Fundus photo taken with a portable handheld camera:
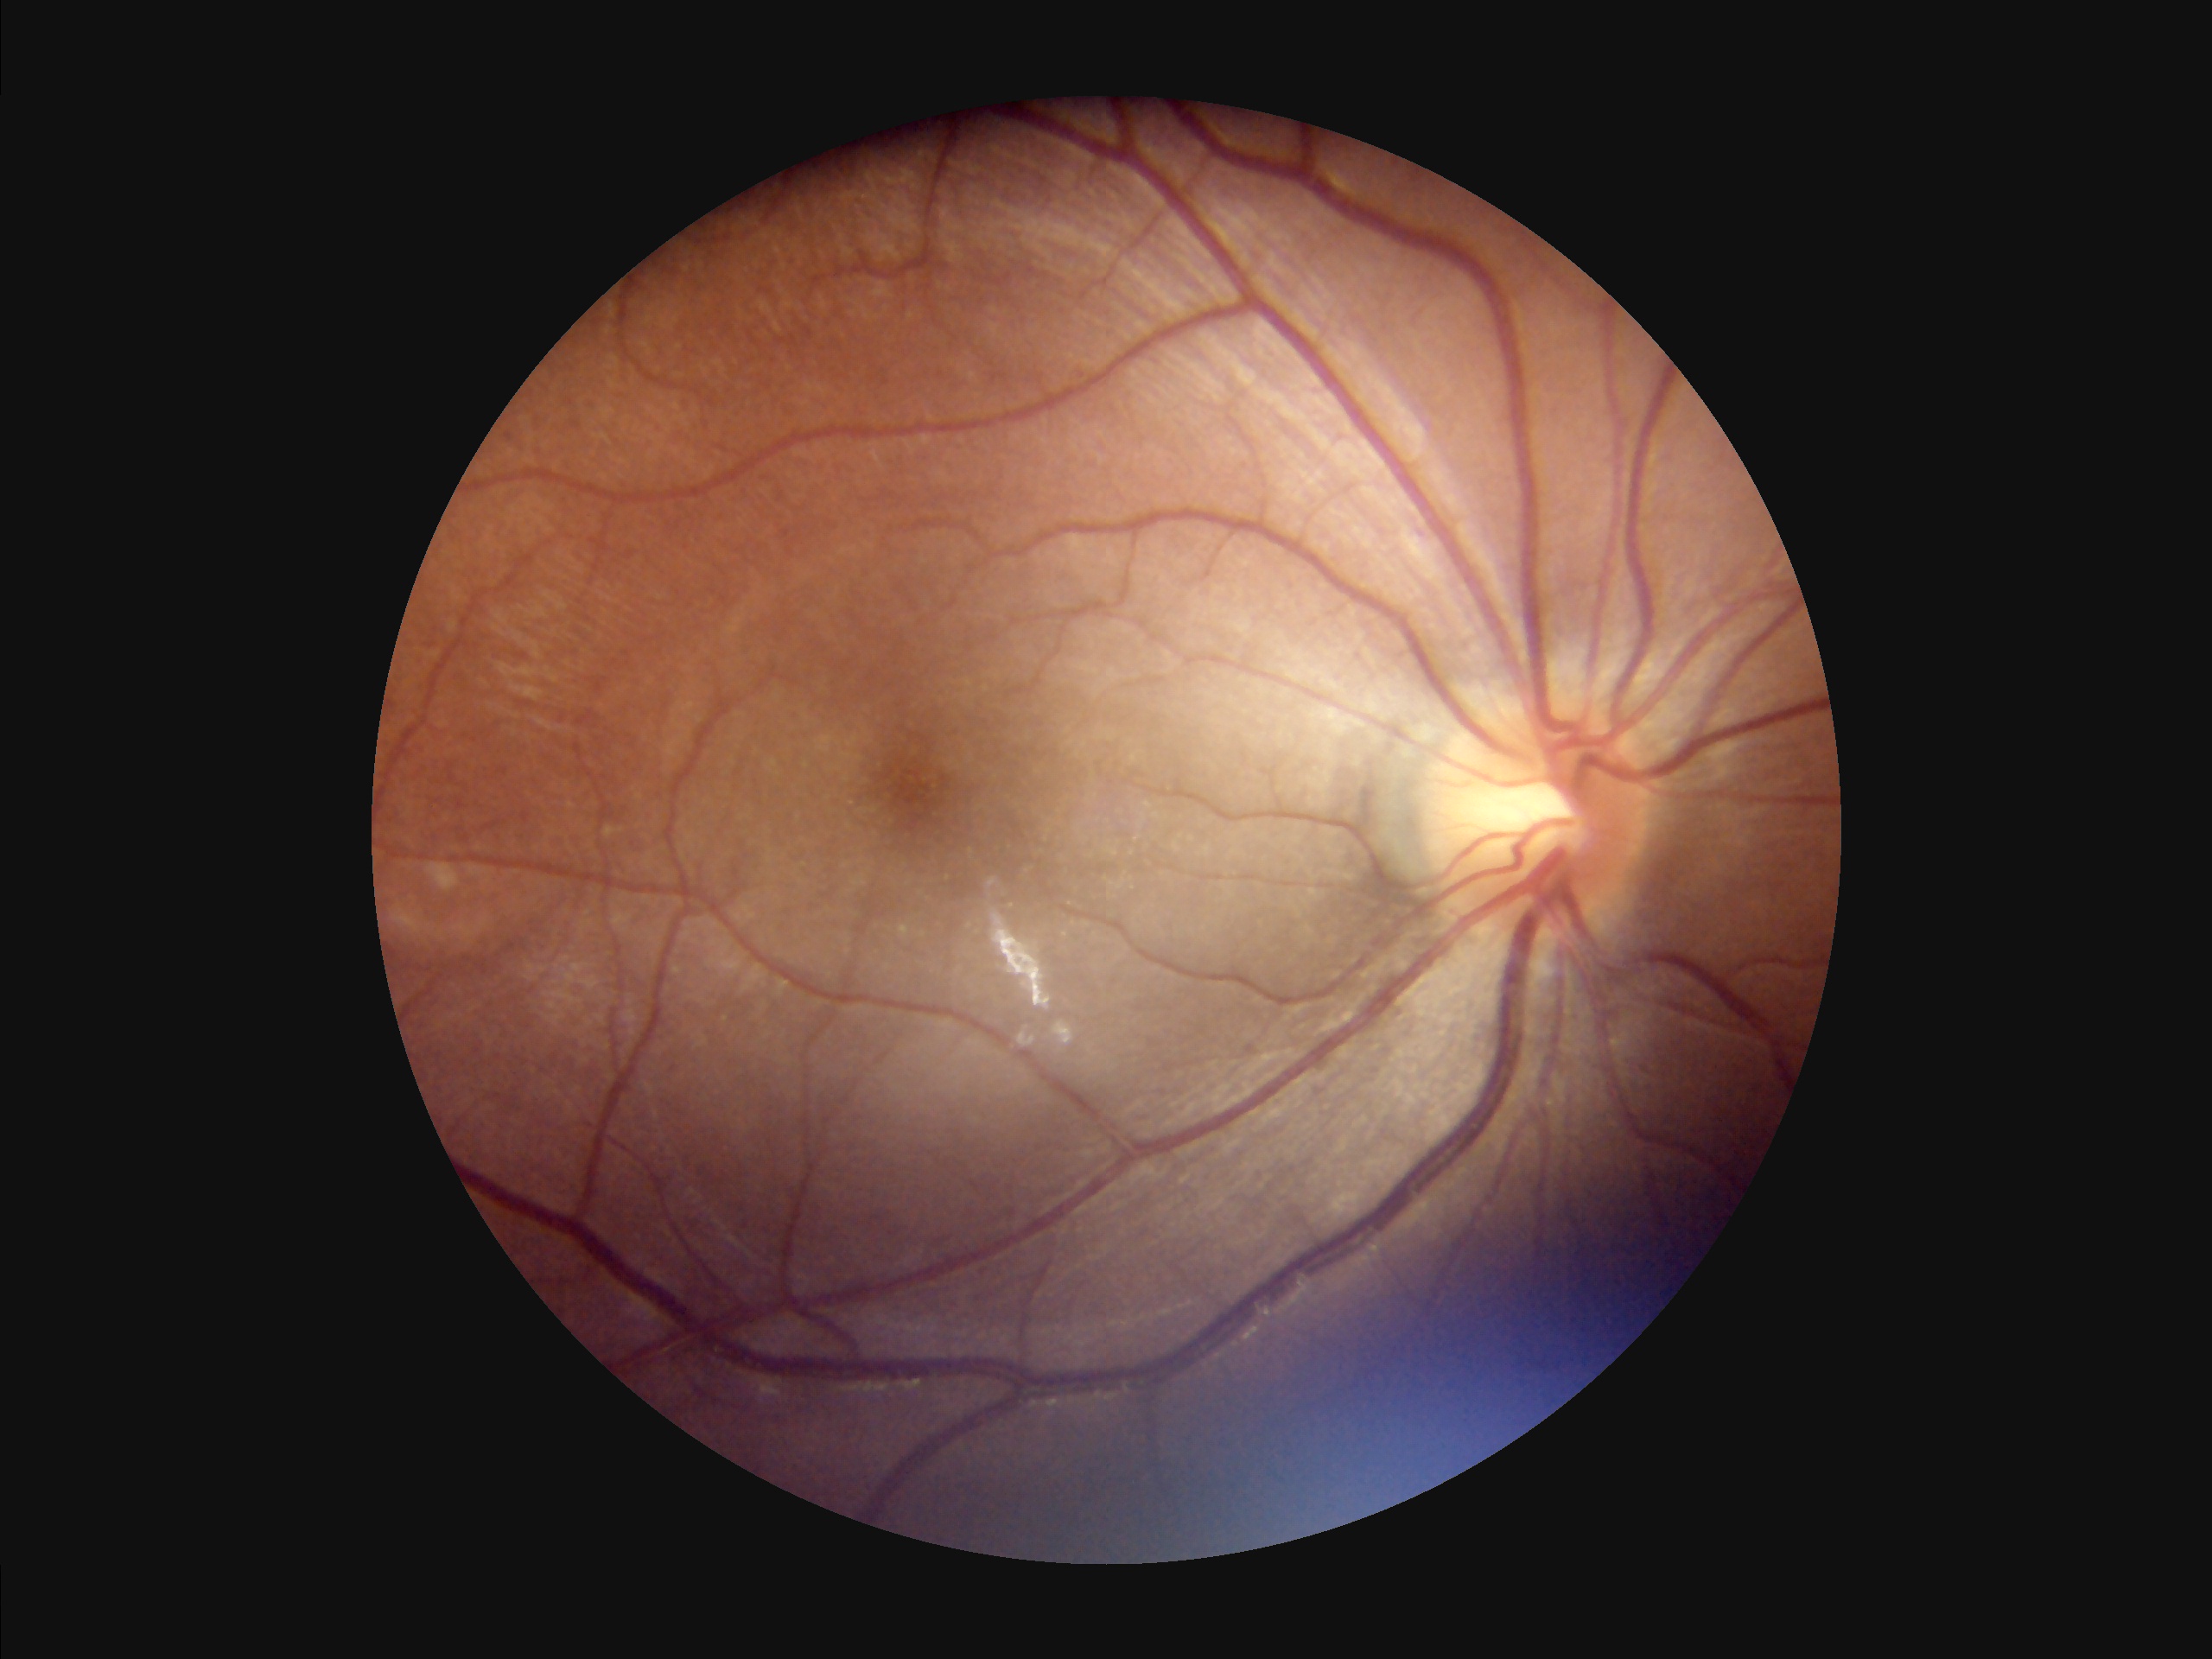

Acceptable image quality. No noticeable blur. Poor illumination with uneven exposure.